Diabetic retinopathy graded by the modified Davis classification
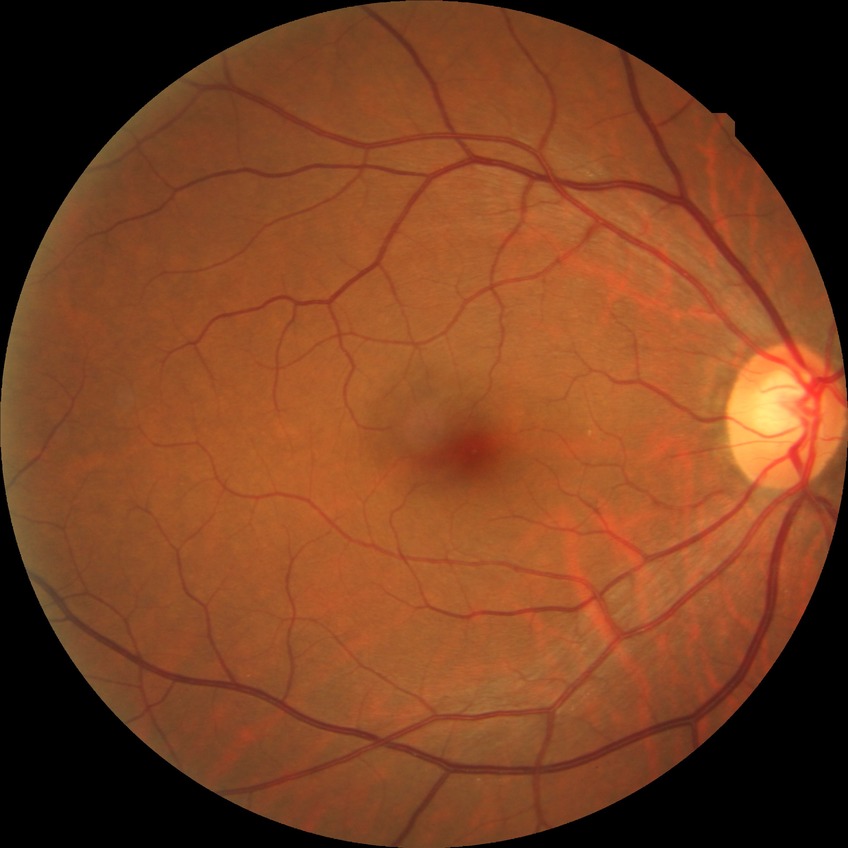

• diabetic retinopathy (DR): no diabetic retinopathy (NDR)